Color fundus image. FOV: 45 degrees
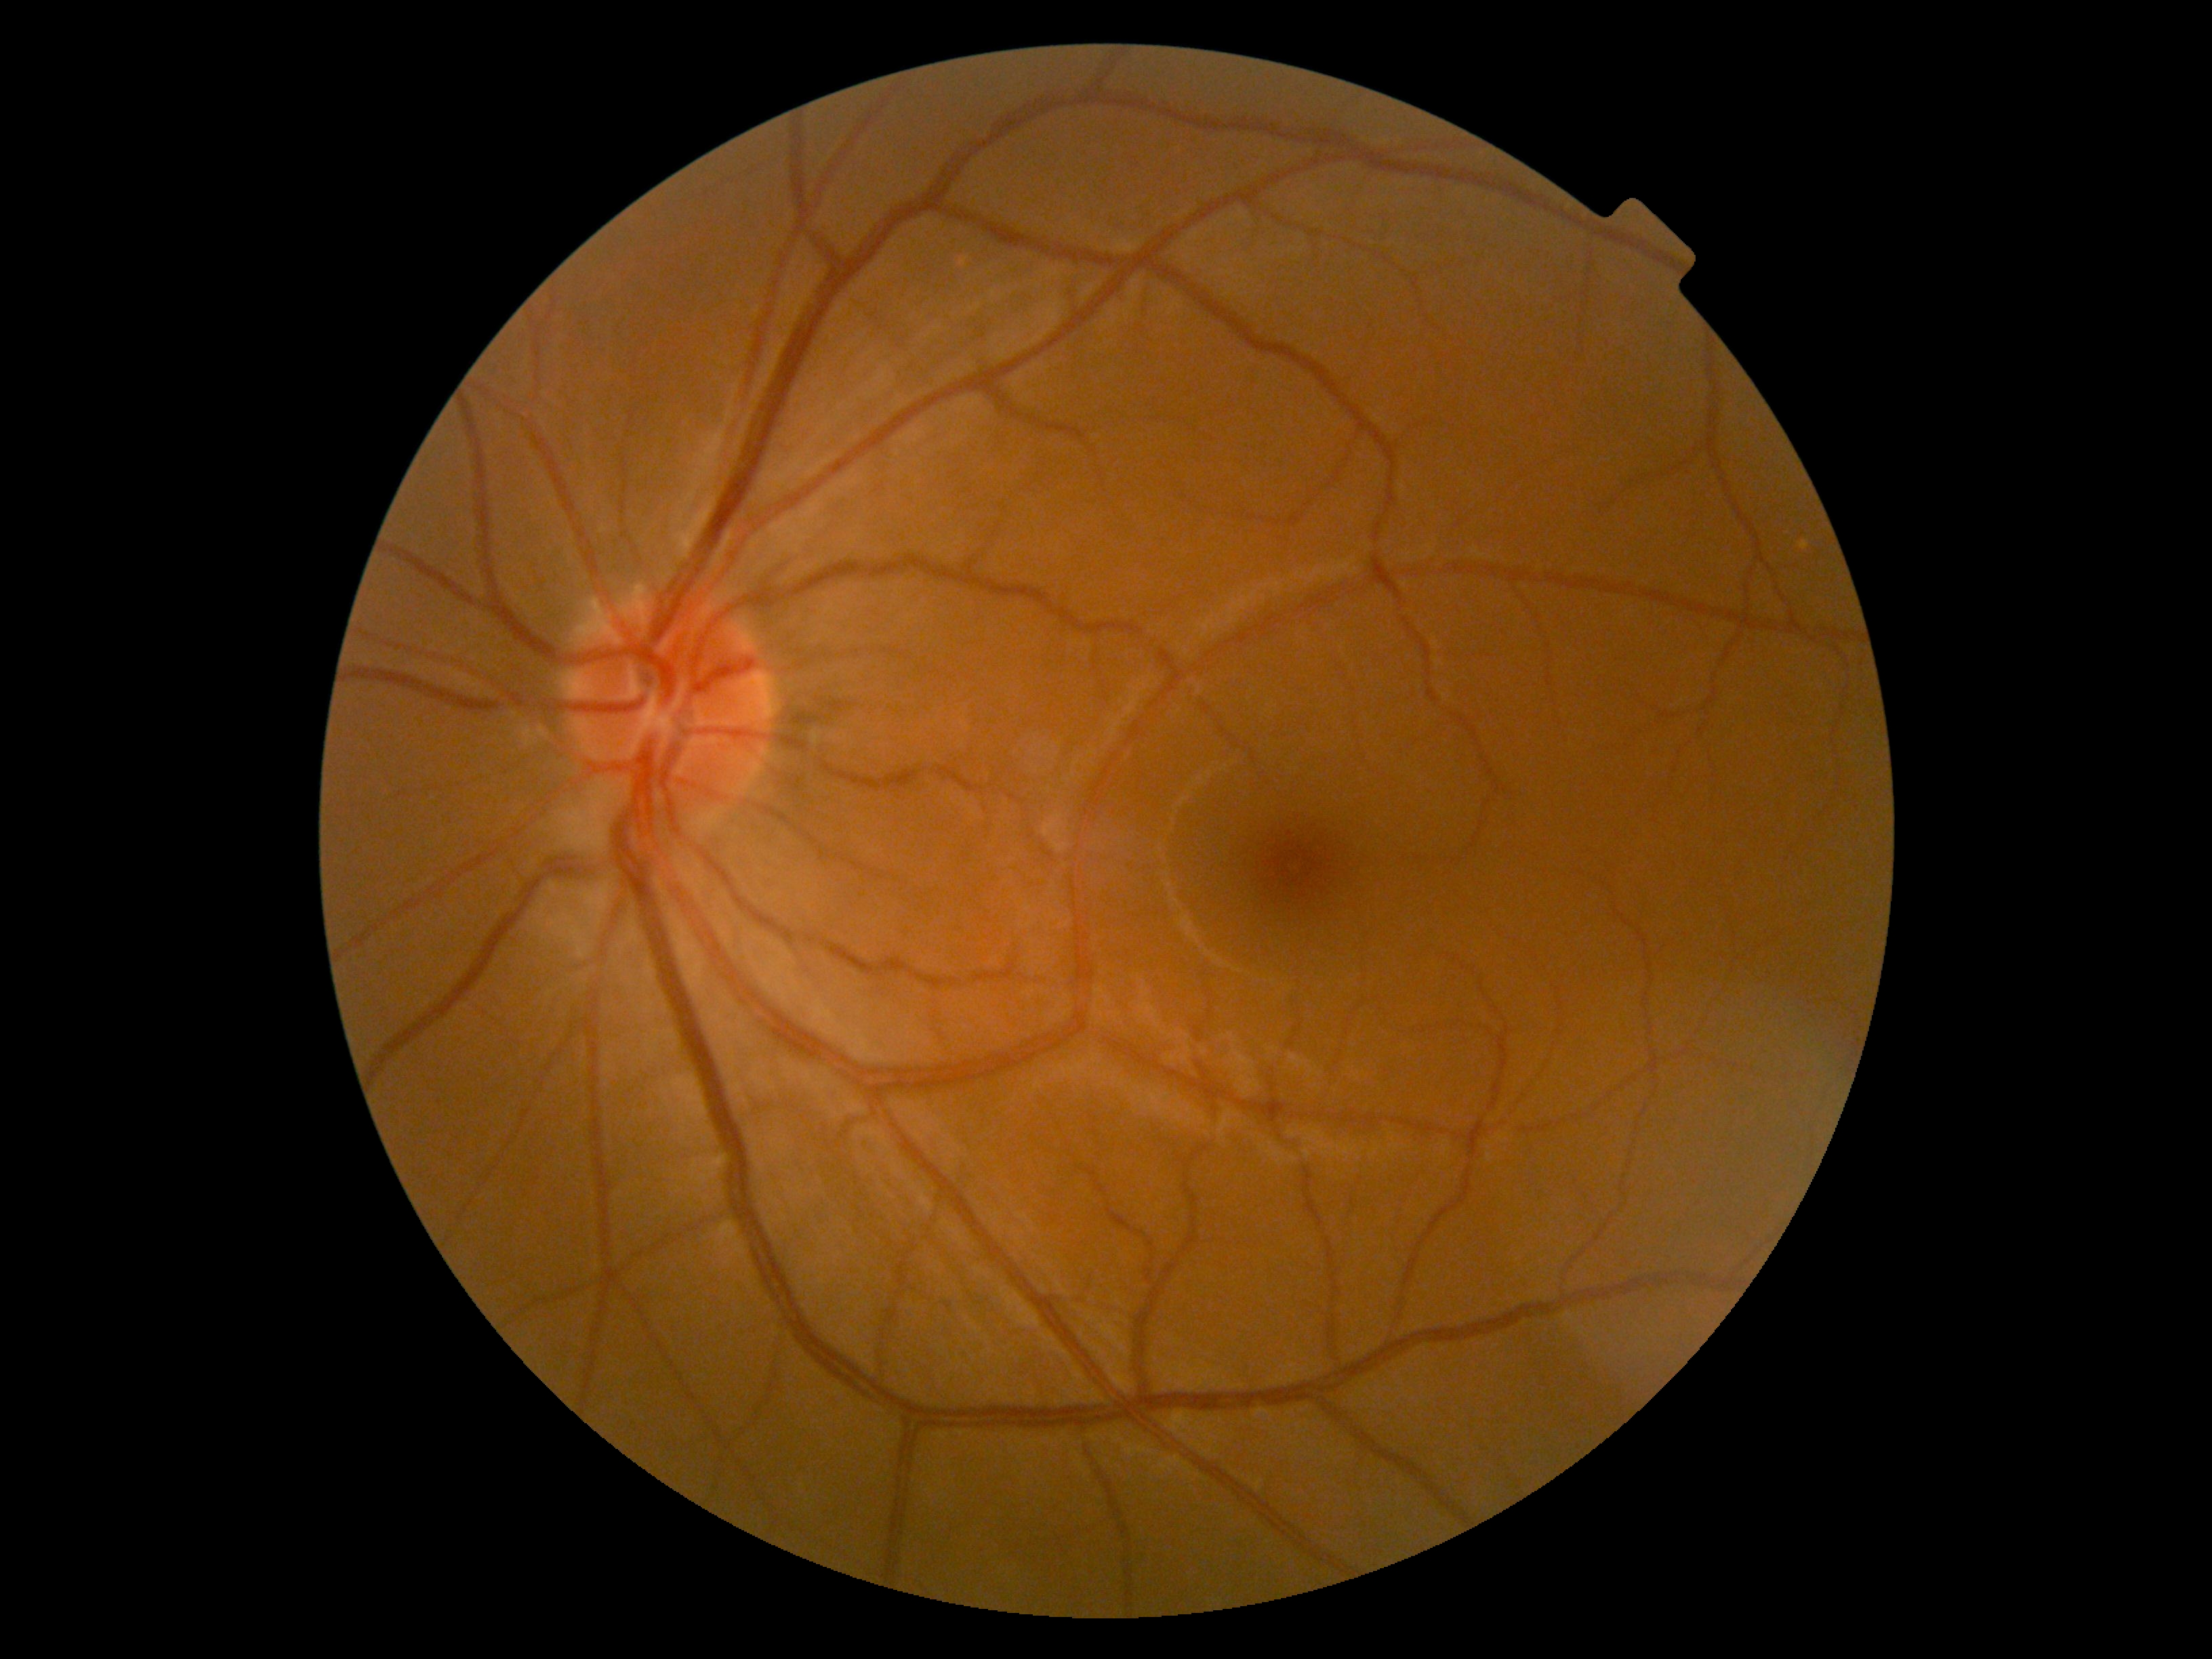
No DR findings.
Diabetic retinopathy (DR) is grade 0 (no apparent retinopathy).